Camera: Clarity RetCam 3 (130° FOV) · 640 x 480 pixels · infant wide-field retinal image
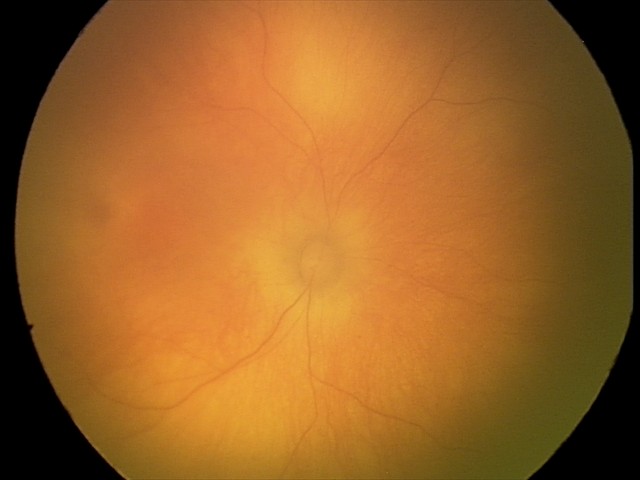 Impression: physiological appearance with no retinal pathology.